848x848px; acquired with a NIDEK AFC-230.
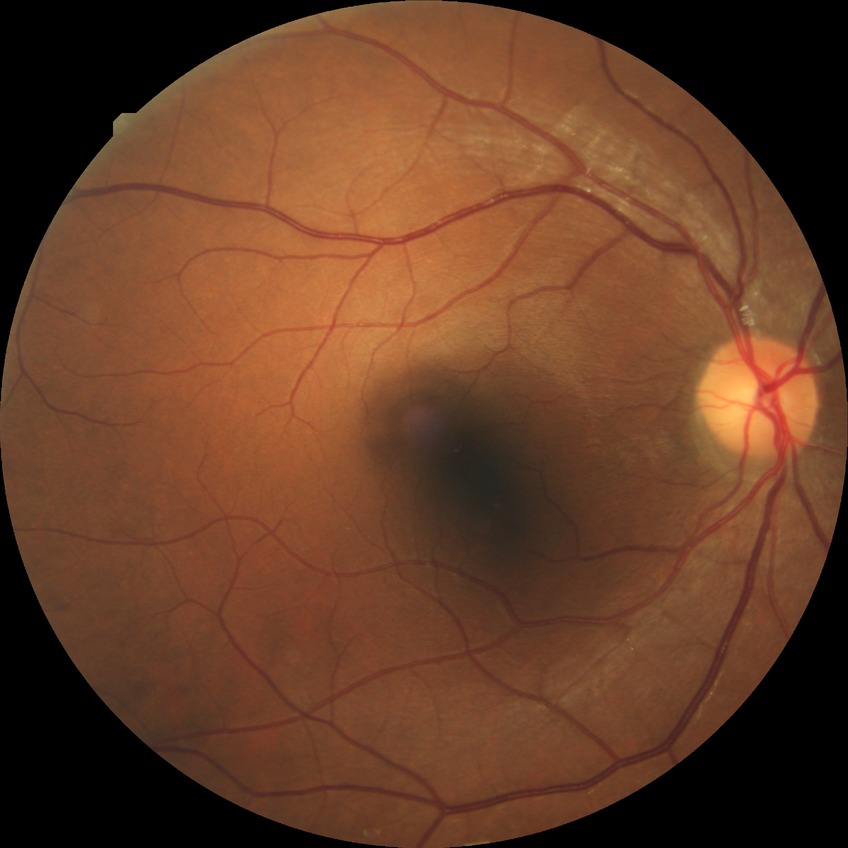

davis_grade: no diabetic retinopathy